CFP — 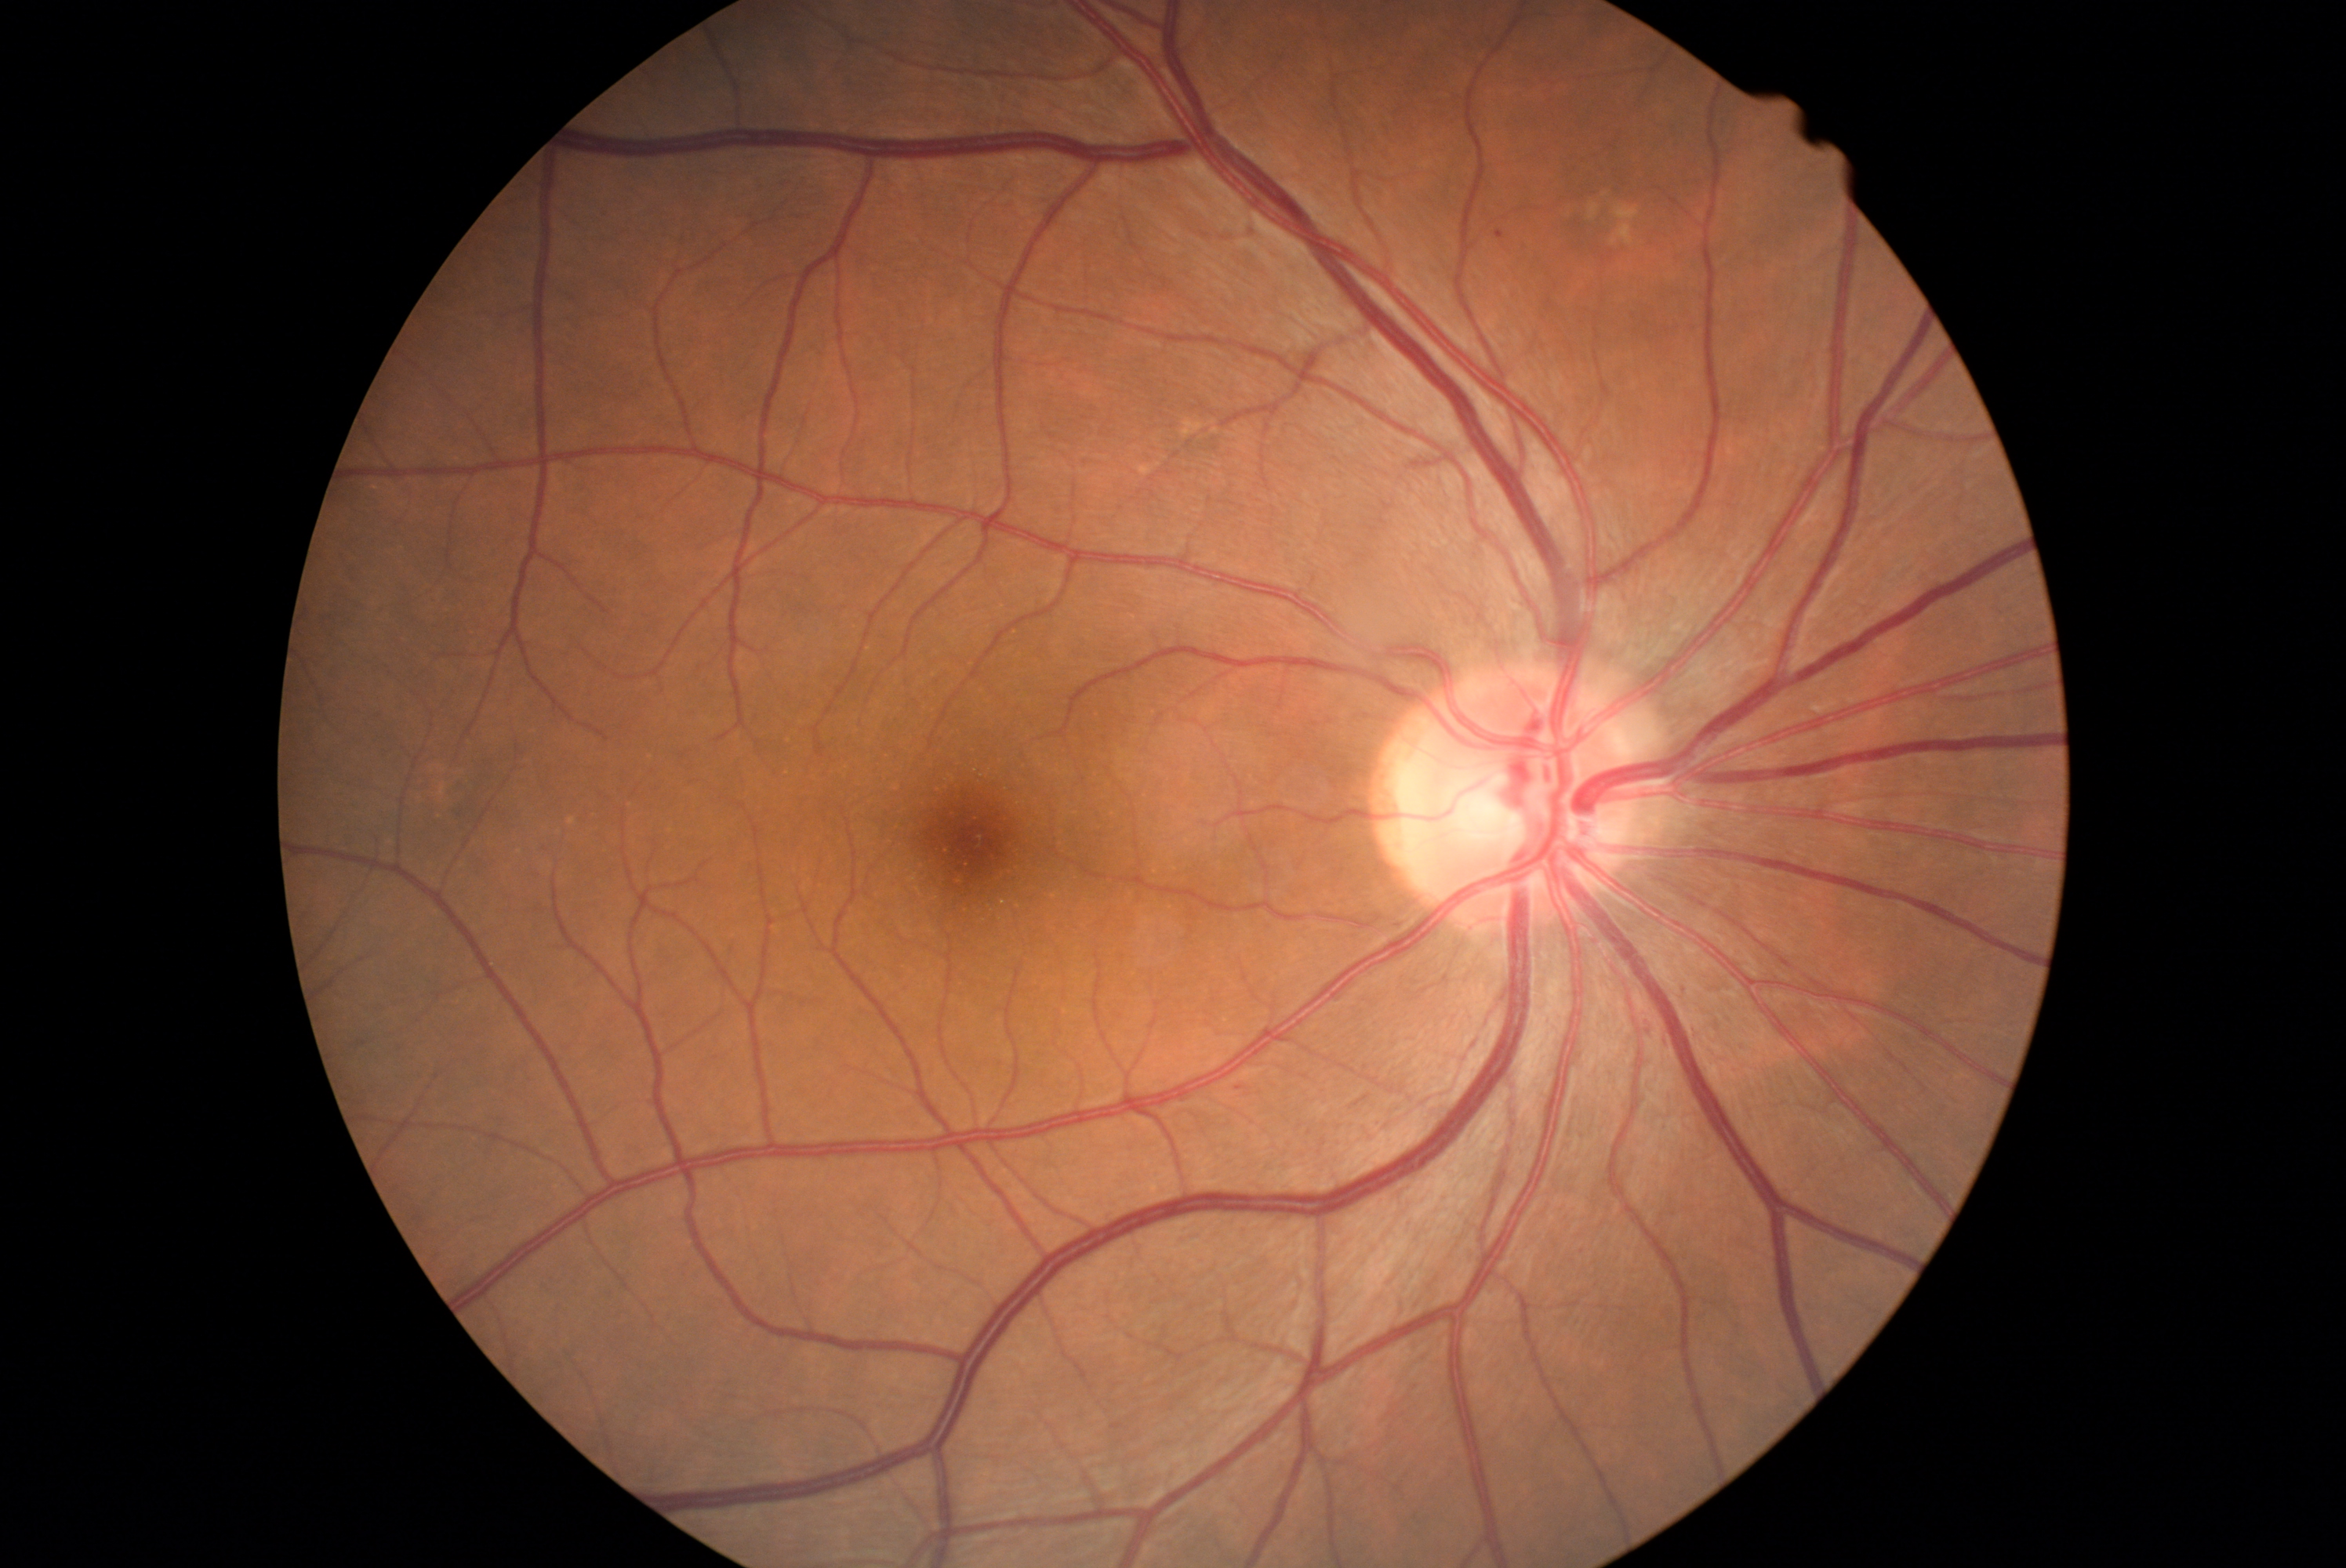
diabetic retinopathy (DR)=grade 1 — presence of microaneurysms only.